848 by 848 pixels:
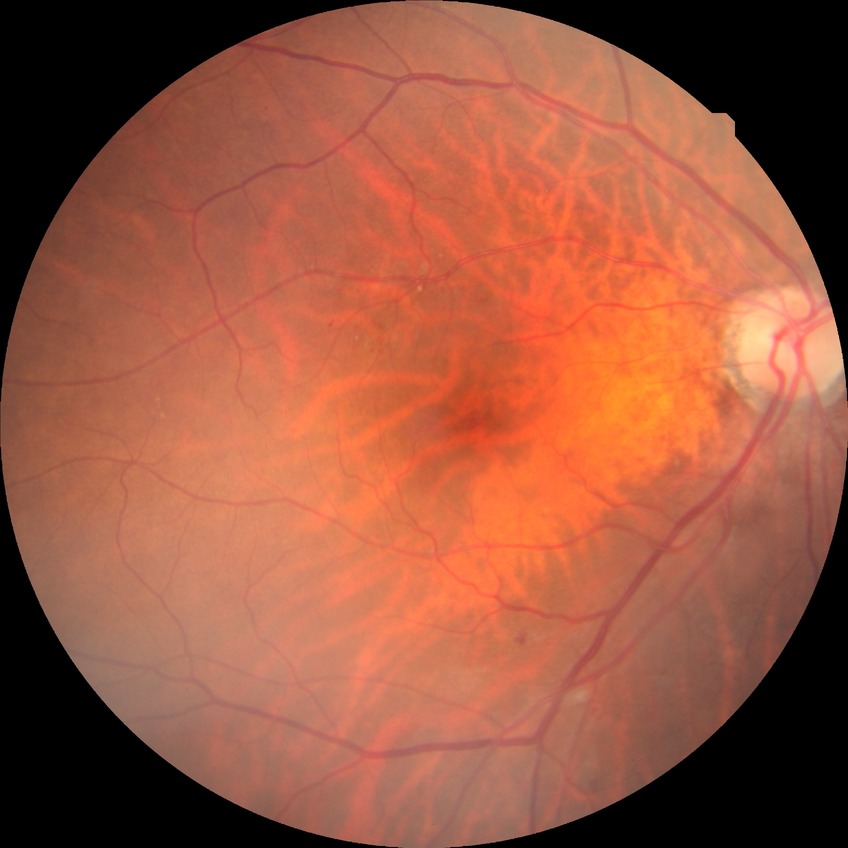

The retinopathy is classified as non-proliferative diabetic retinopathy. Retinopathy grade: simple diabetic retinopathy.